Infant wide-field fundus photograph: 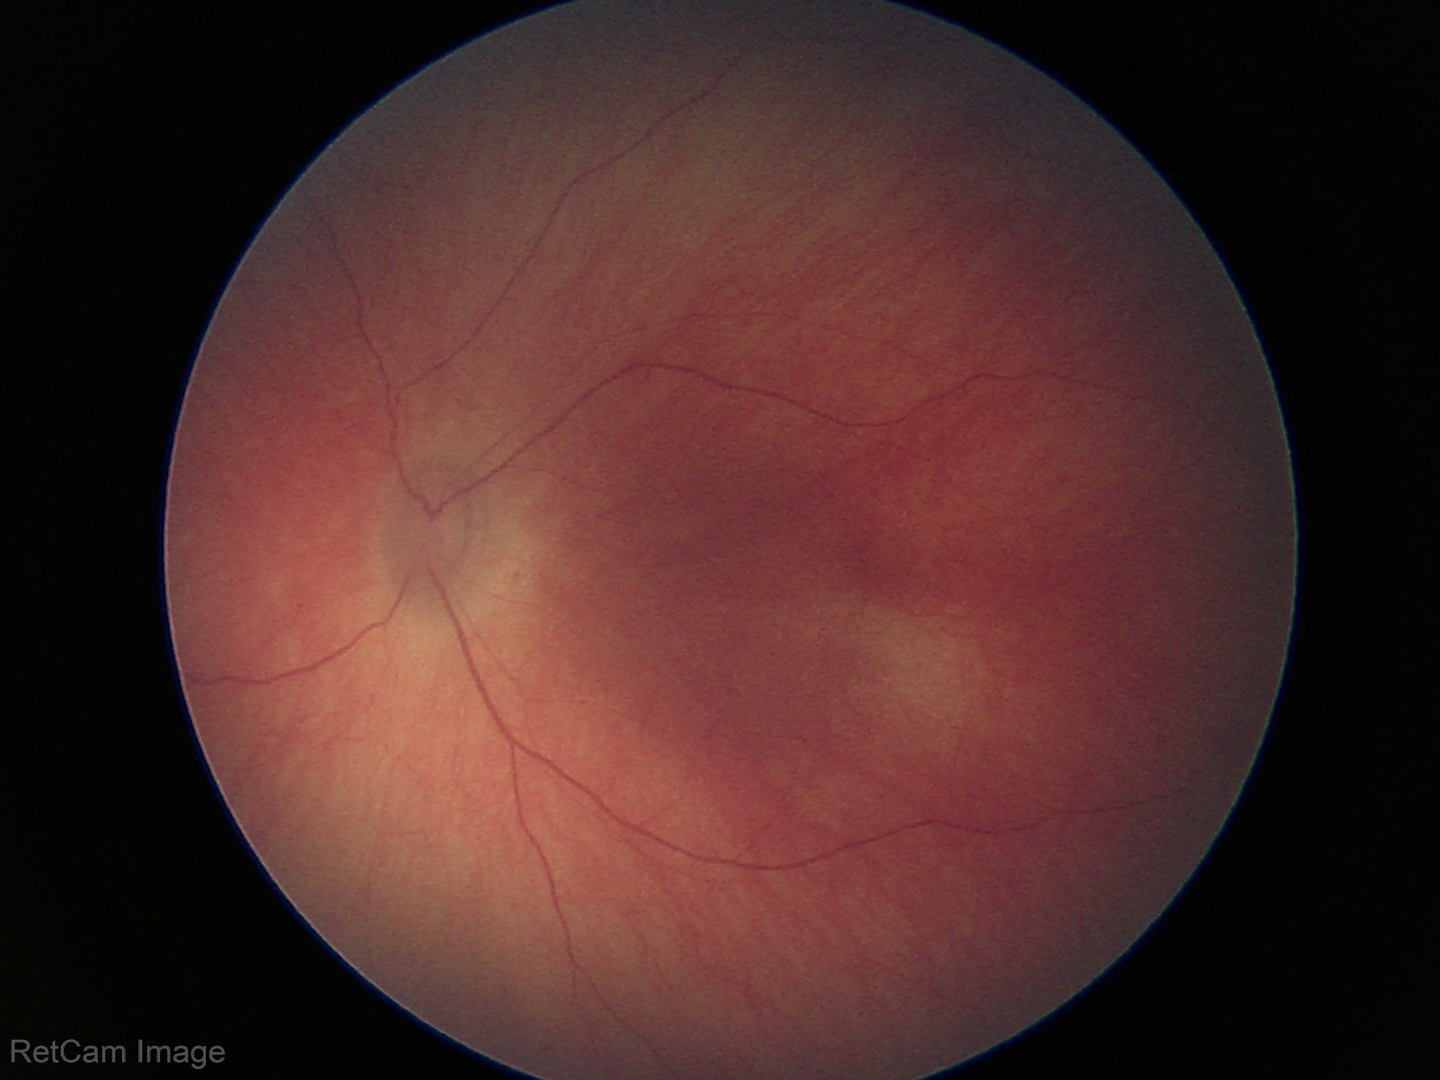 Assessment: physiological appearance with no retinal pathology.